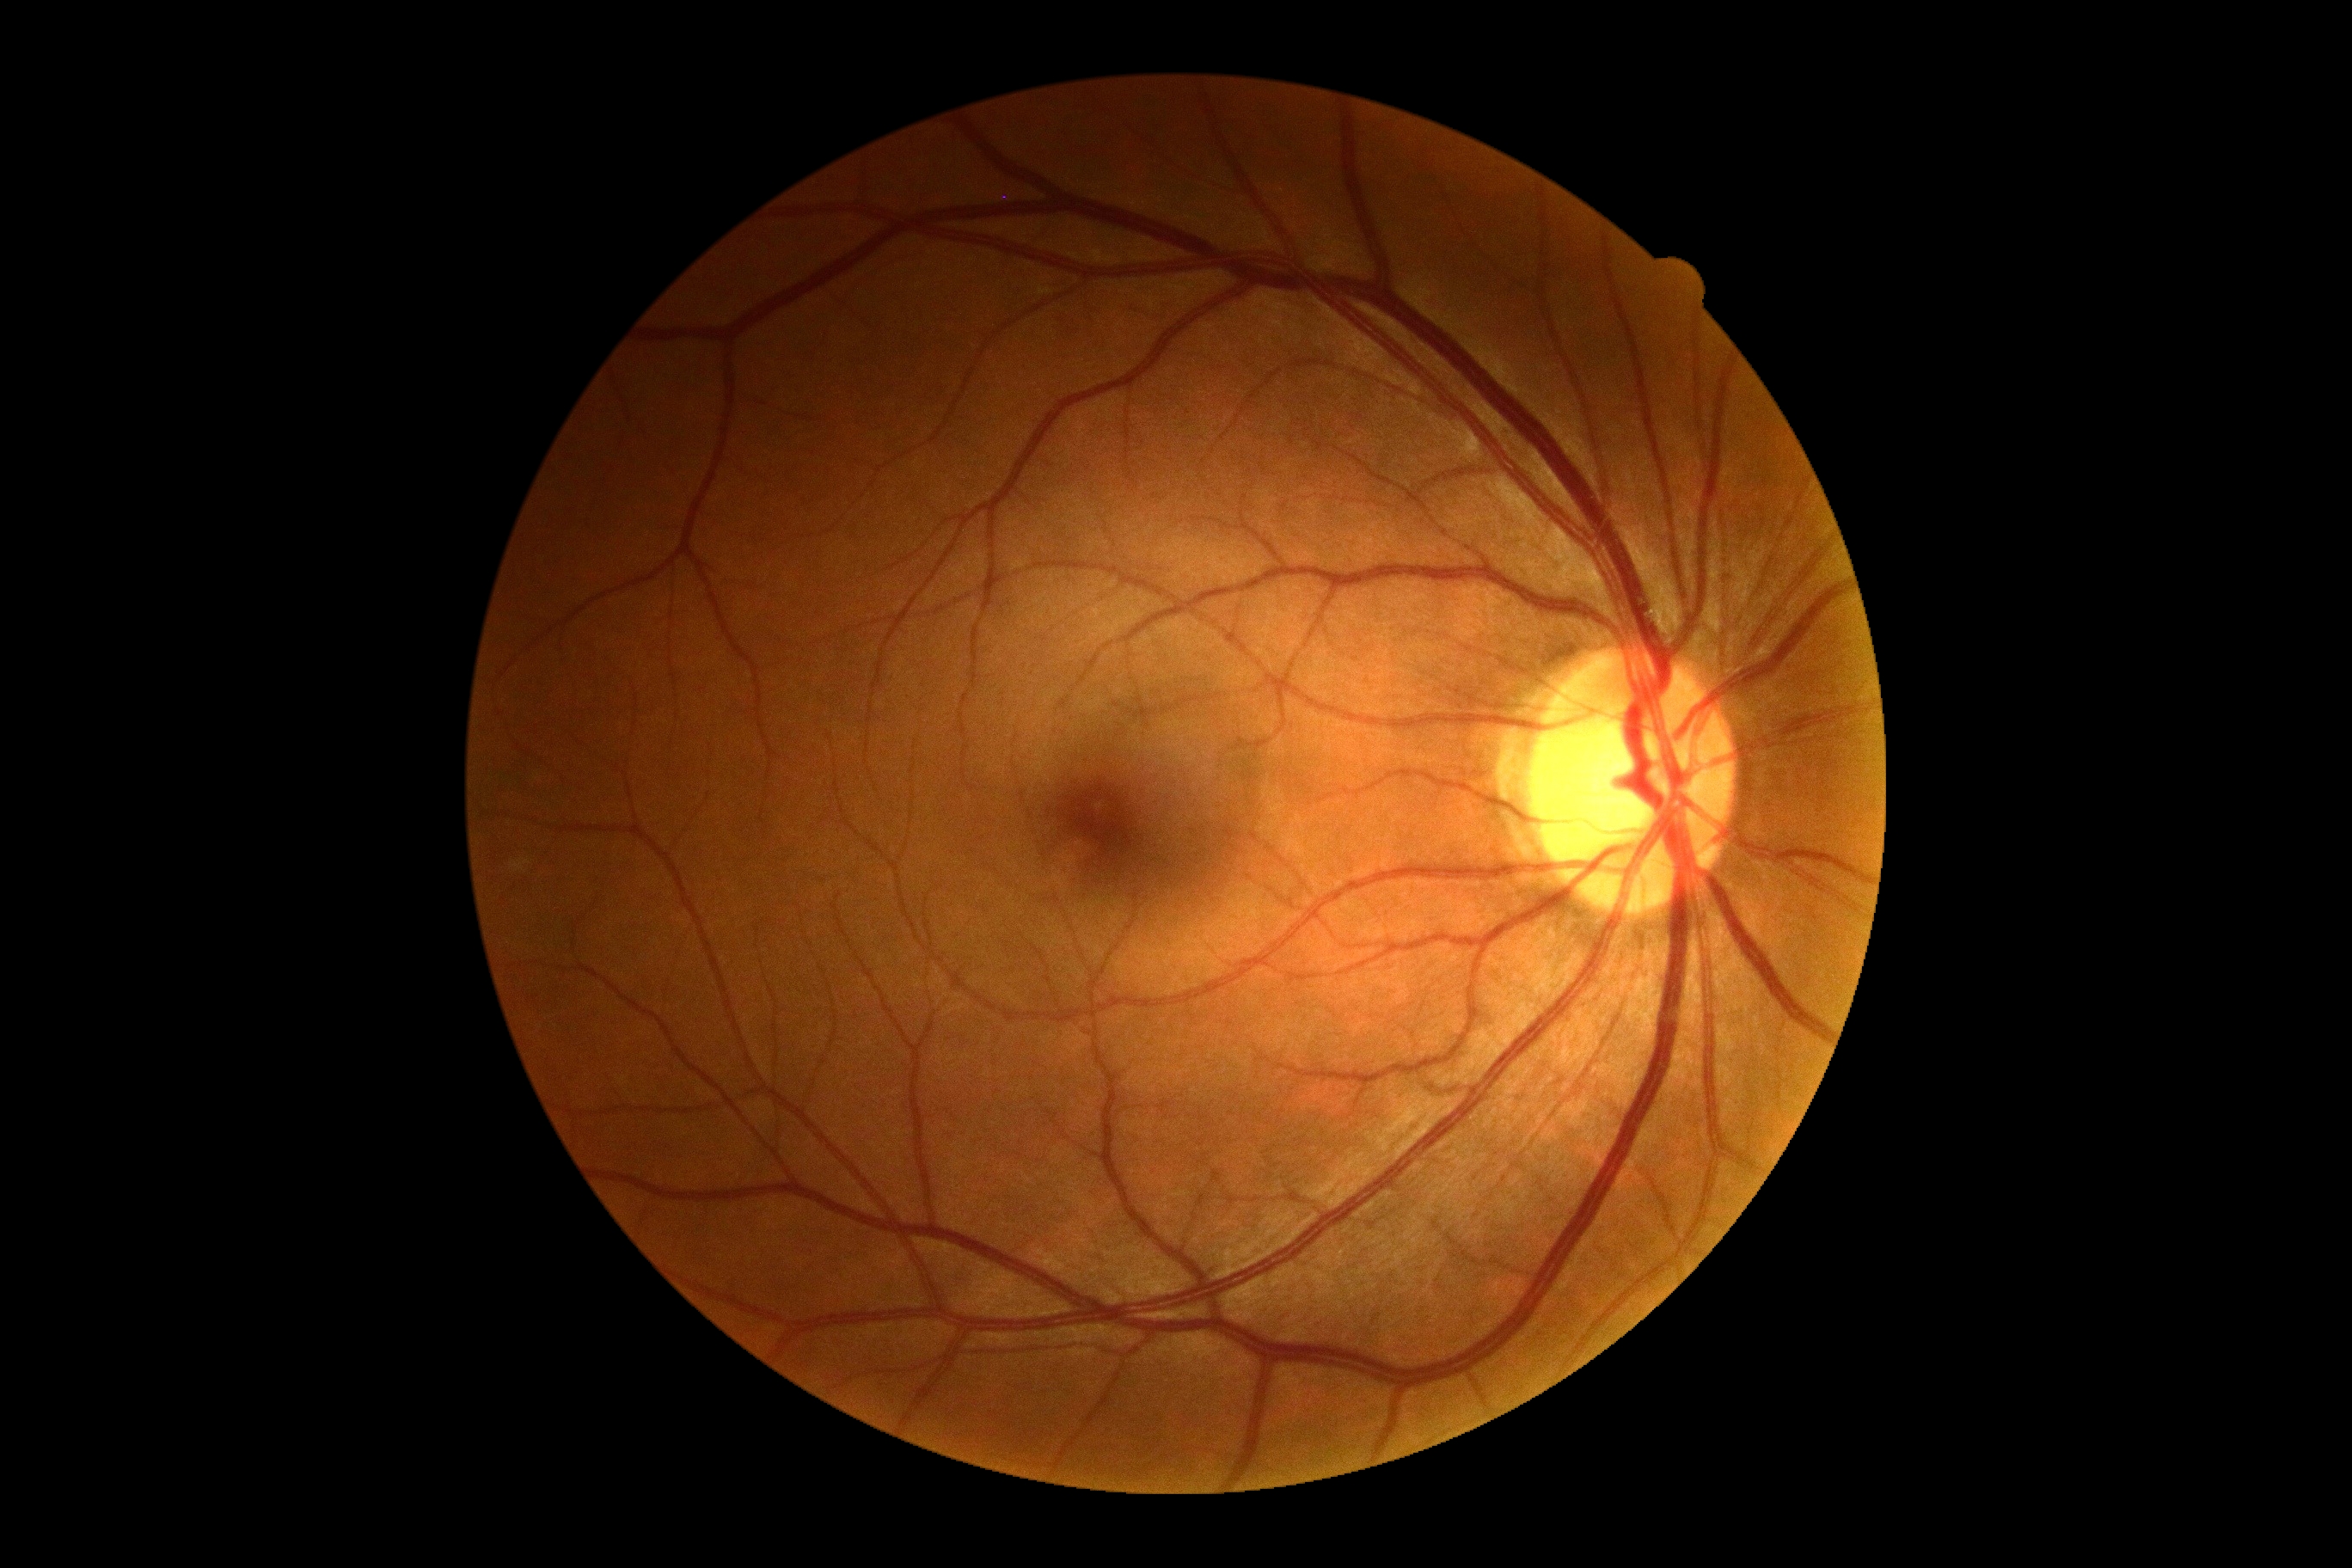 Diabetic retinopathy grade: 0.